Camera: NIDEK AFC-230; retinal fundus photograph; nonmydriatic fundus photograph; DR severity per modified Davis staging:
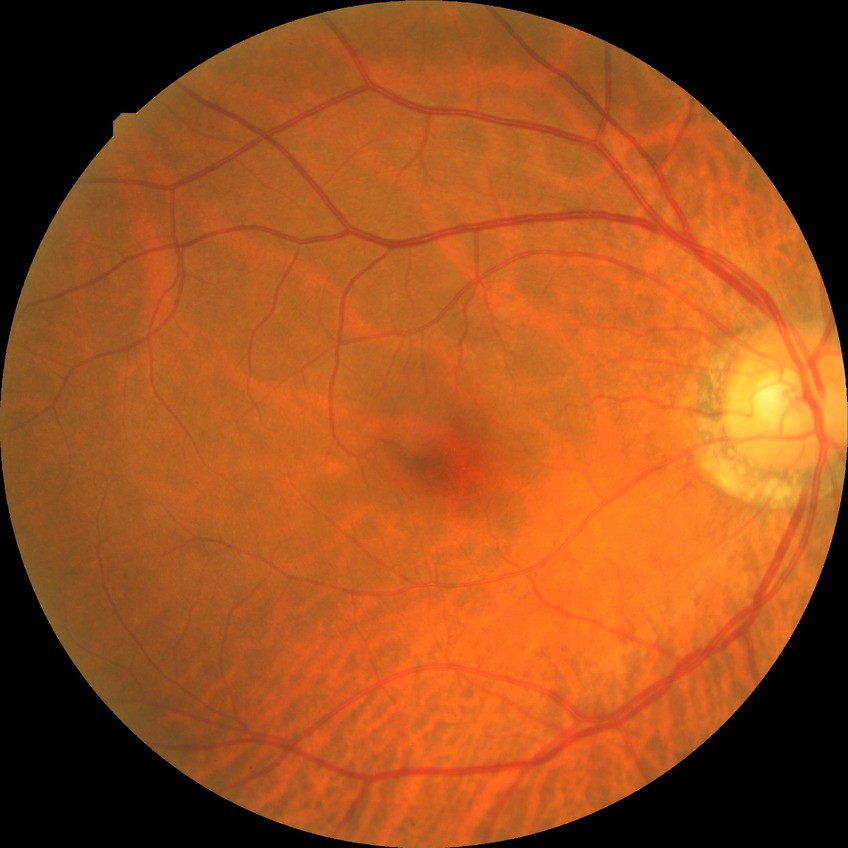

Diabetic retinopathy (DR): no diabetic retinopathy (NDR).